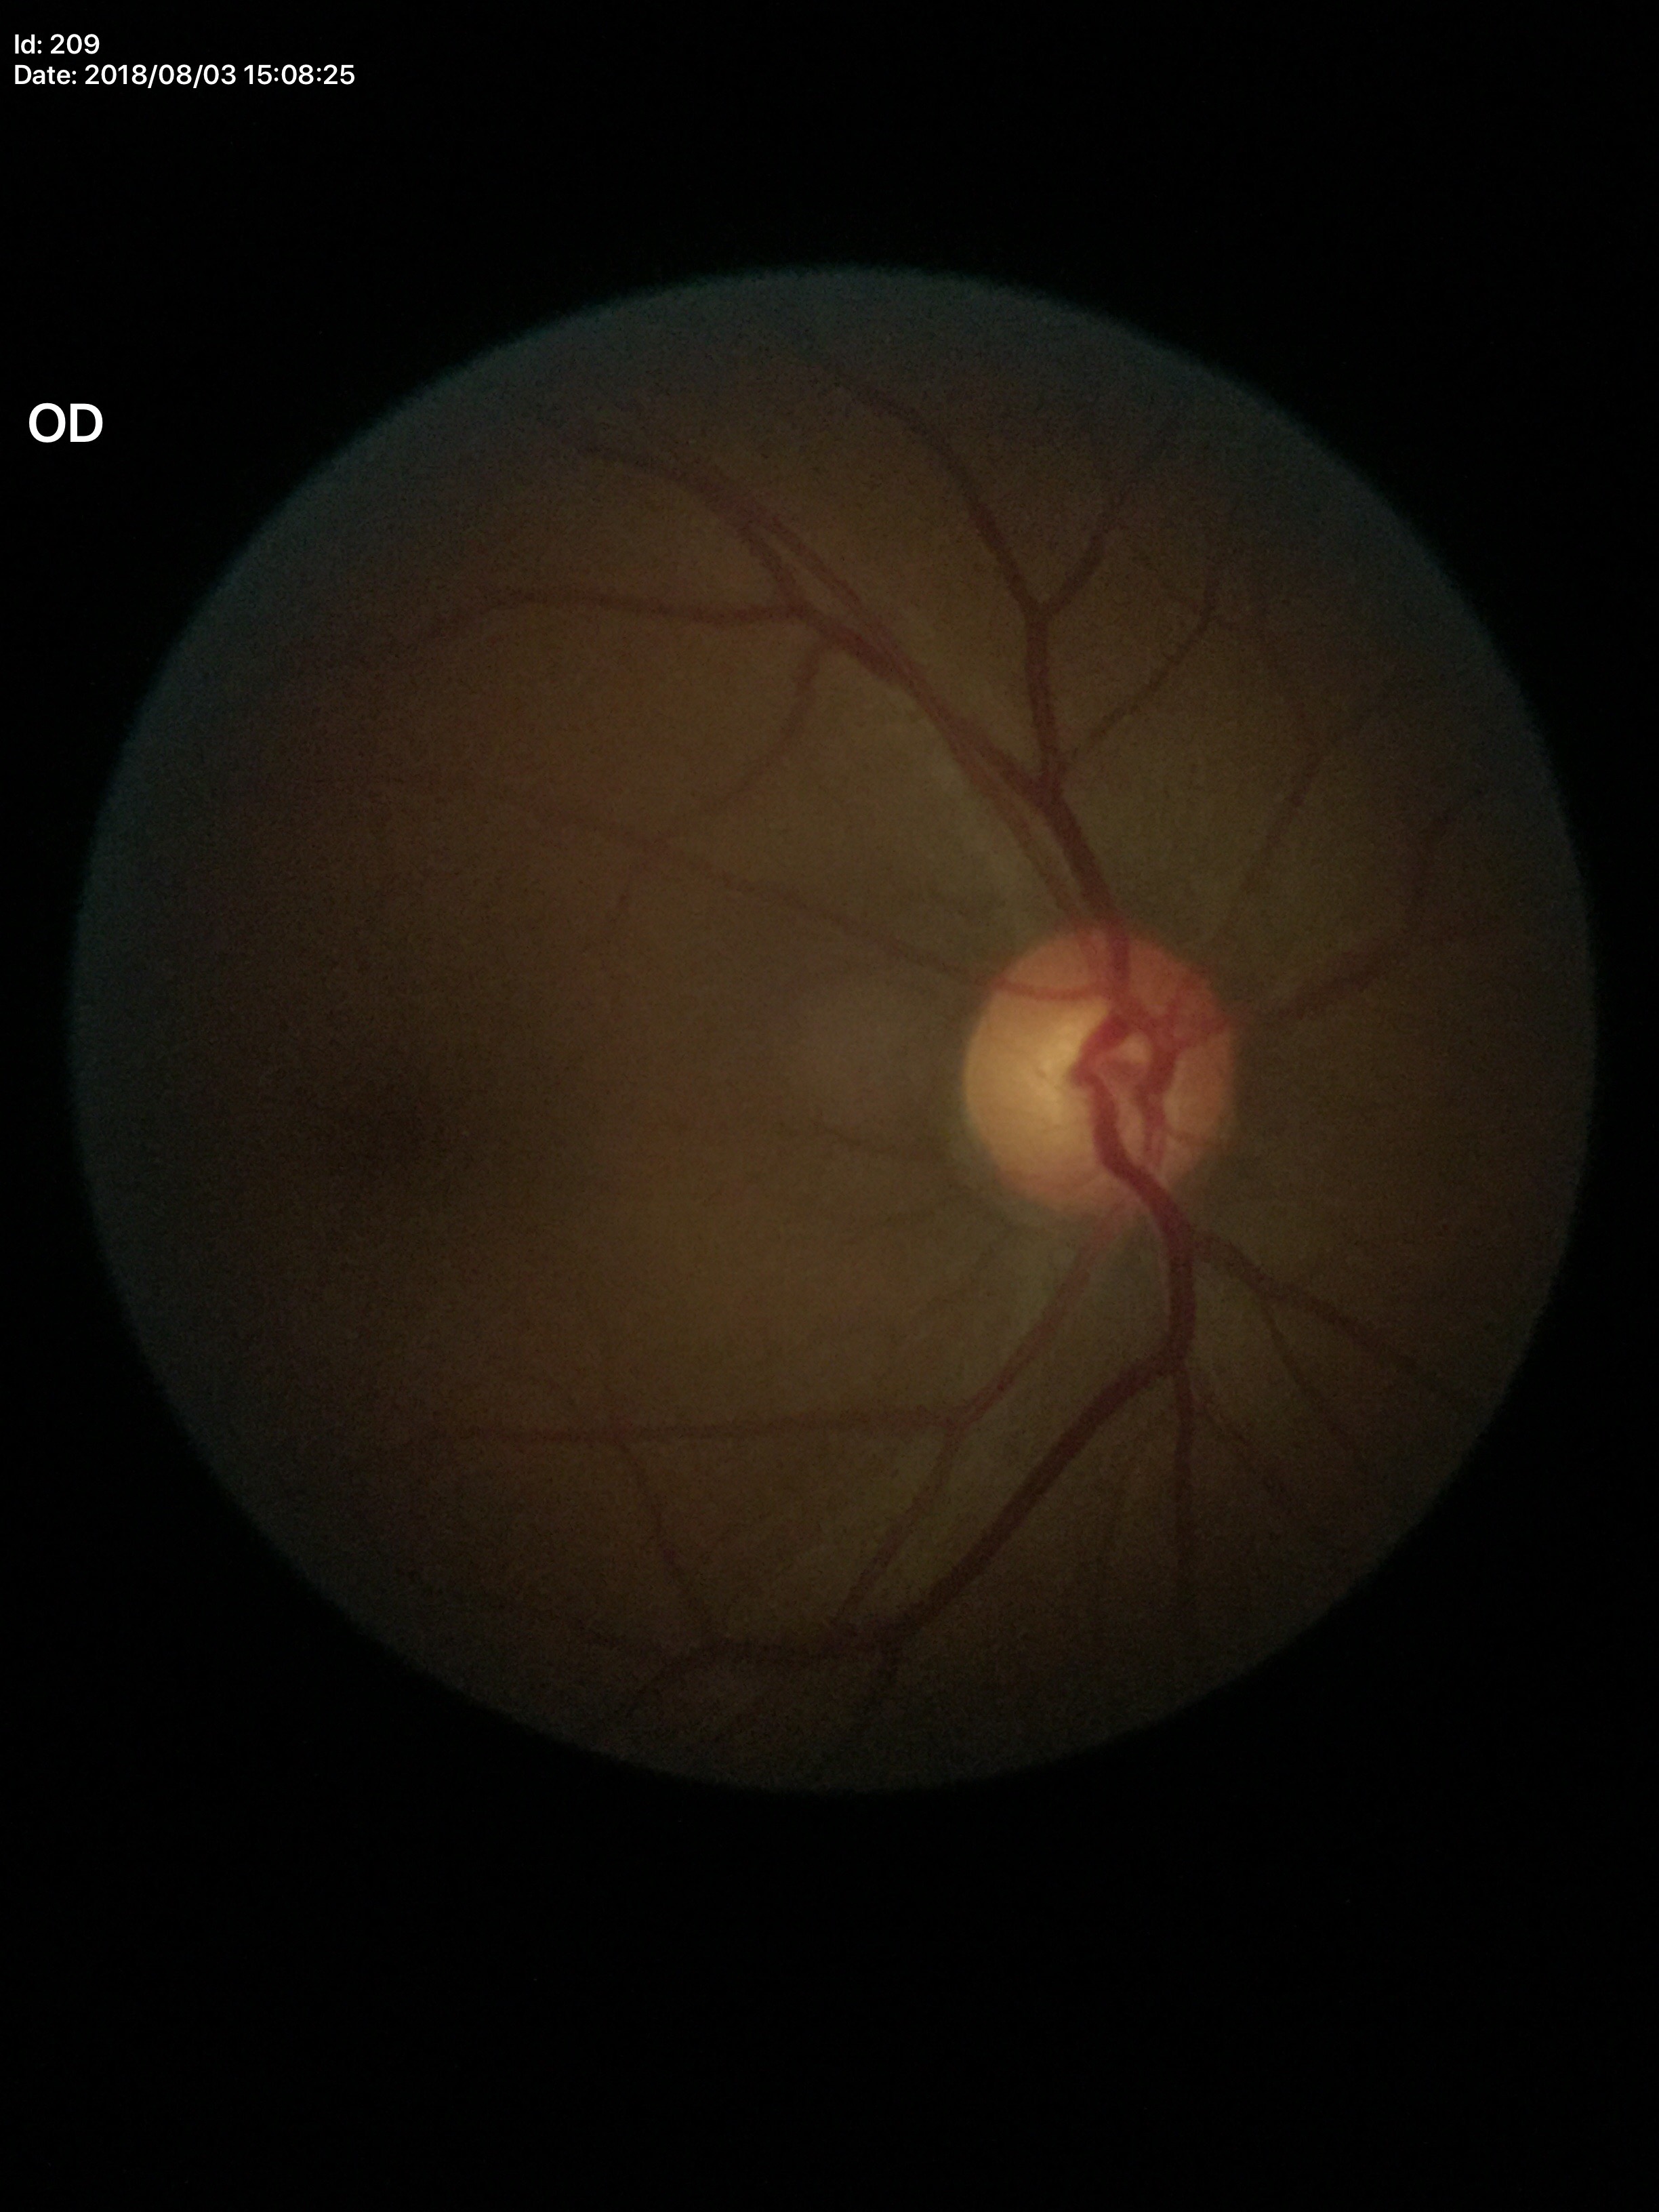 Glaucoma assessment: not suspect. Vertical C/D ratio is 0.58. Horizontal C/D ratio: 0.52.